Acquired on the Phoenix ICON · 1240x1240px · infant wide-field retinal image:
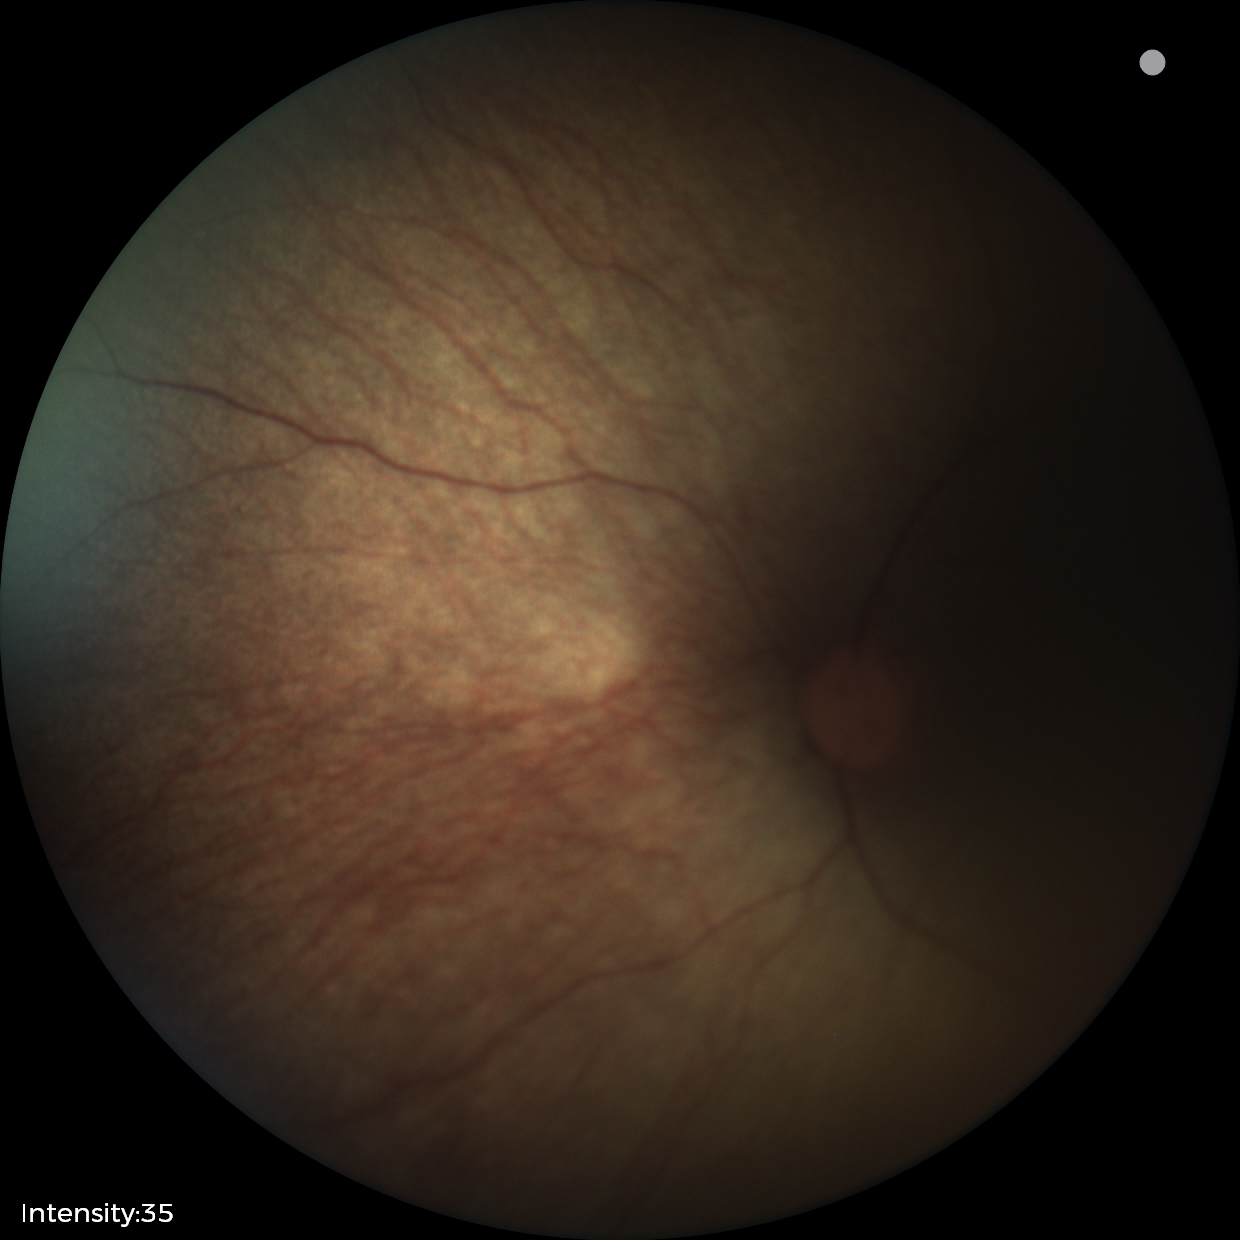 Impression: no abnormal retinal findings.